CFP.
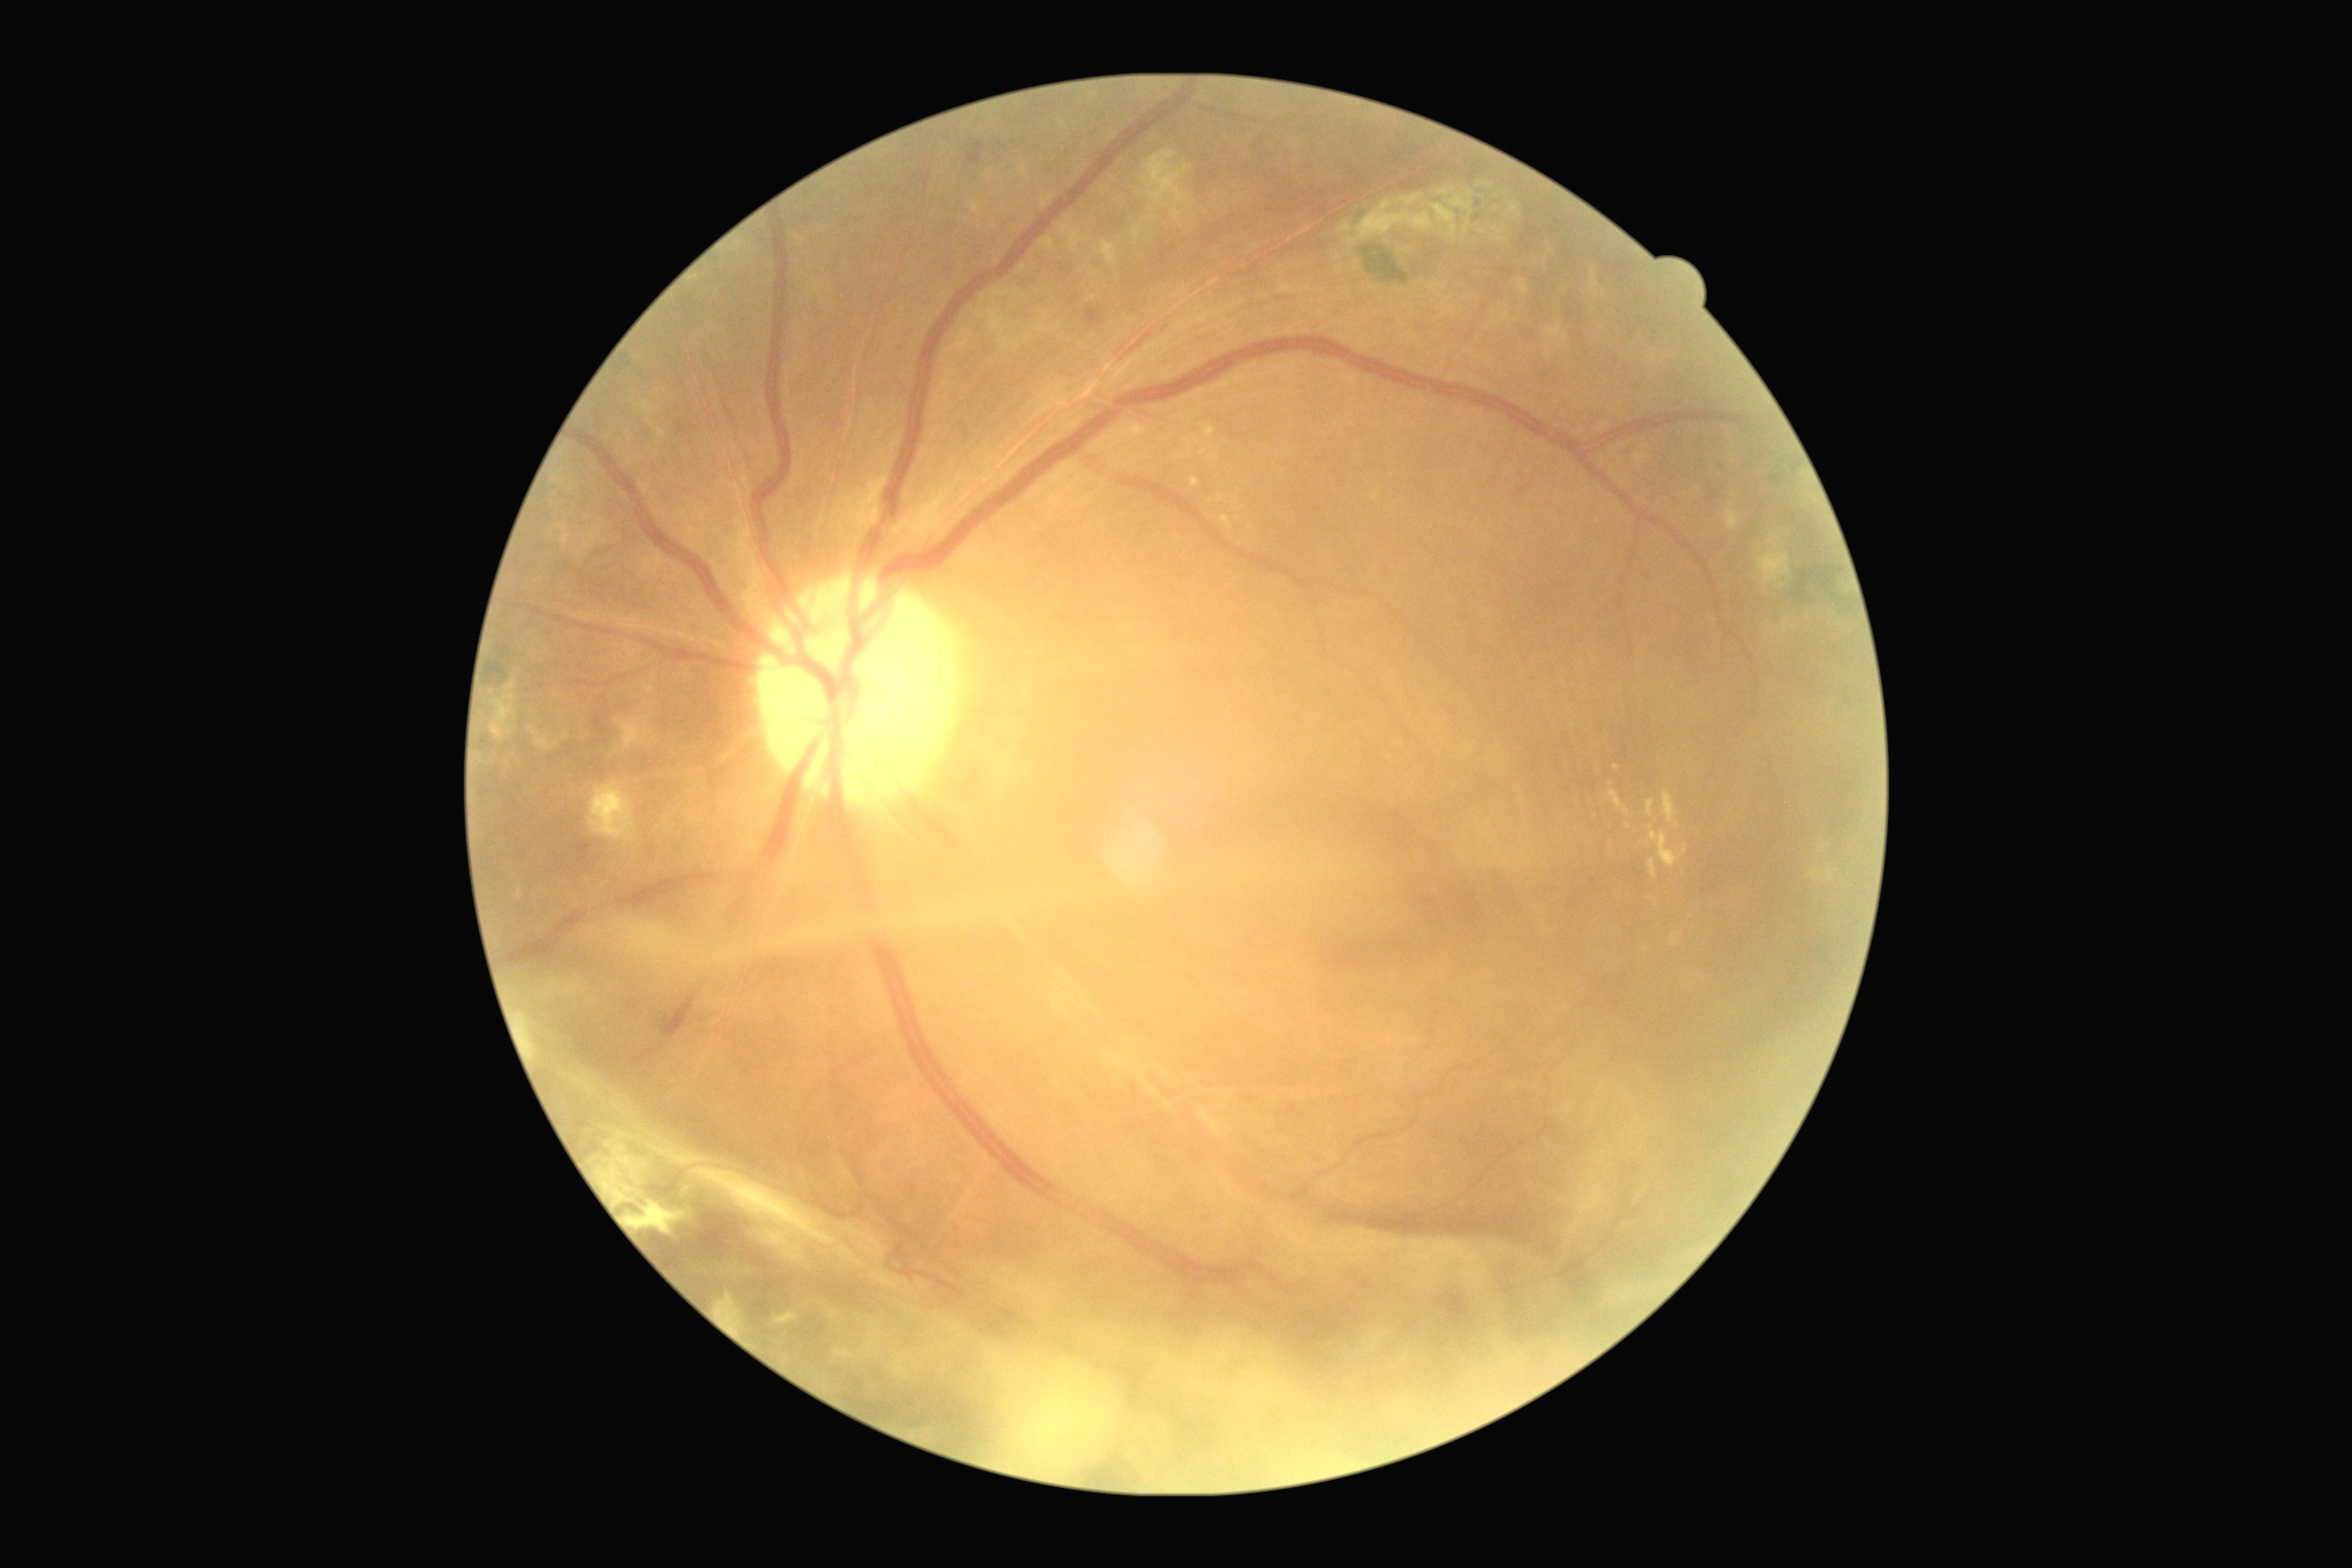 Diabetic retinopathy severity: grade 4. DR class: proliferative diabetic retinopathy.